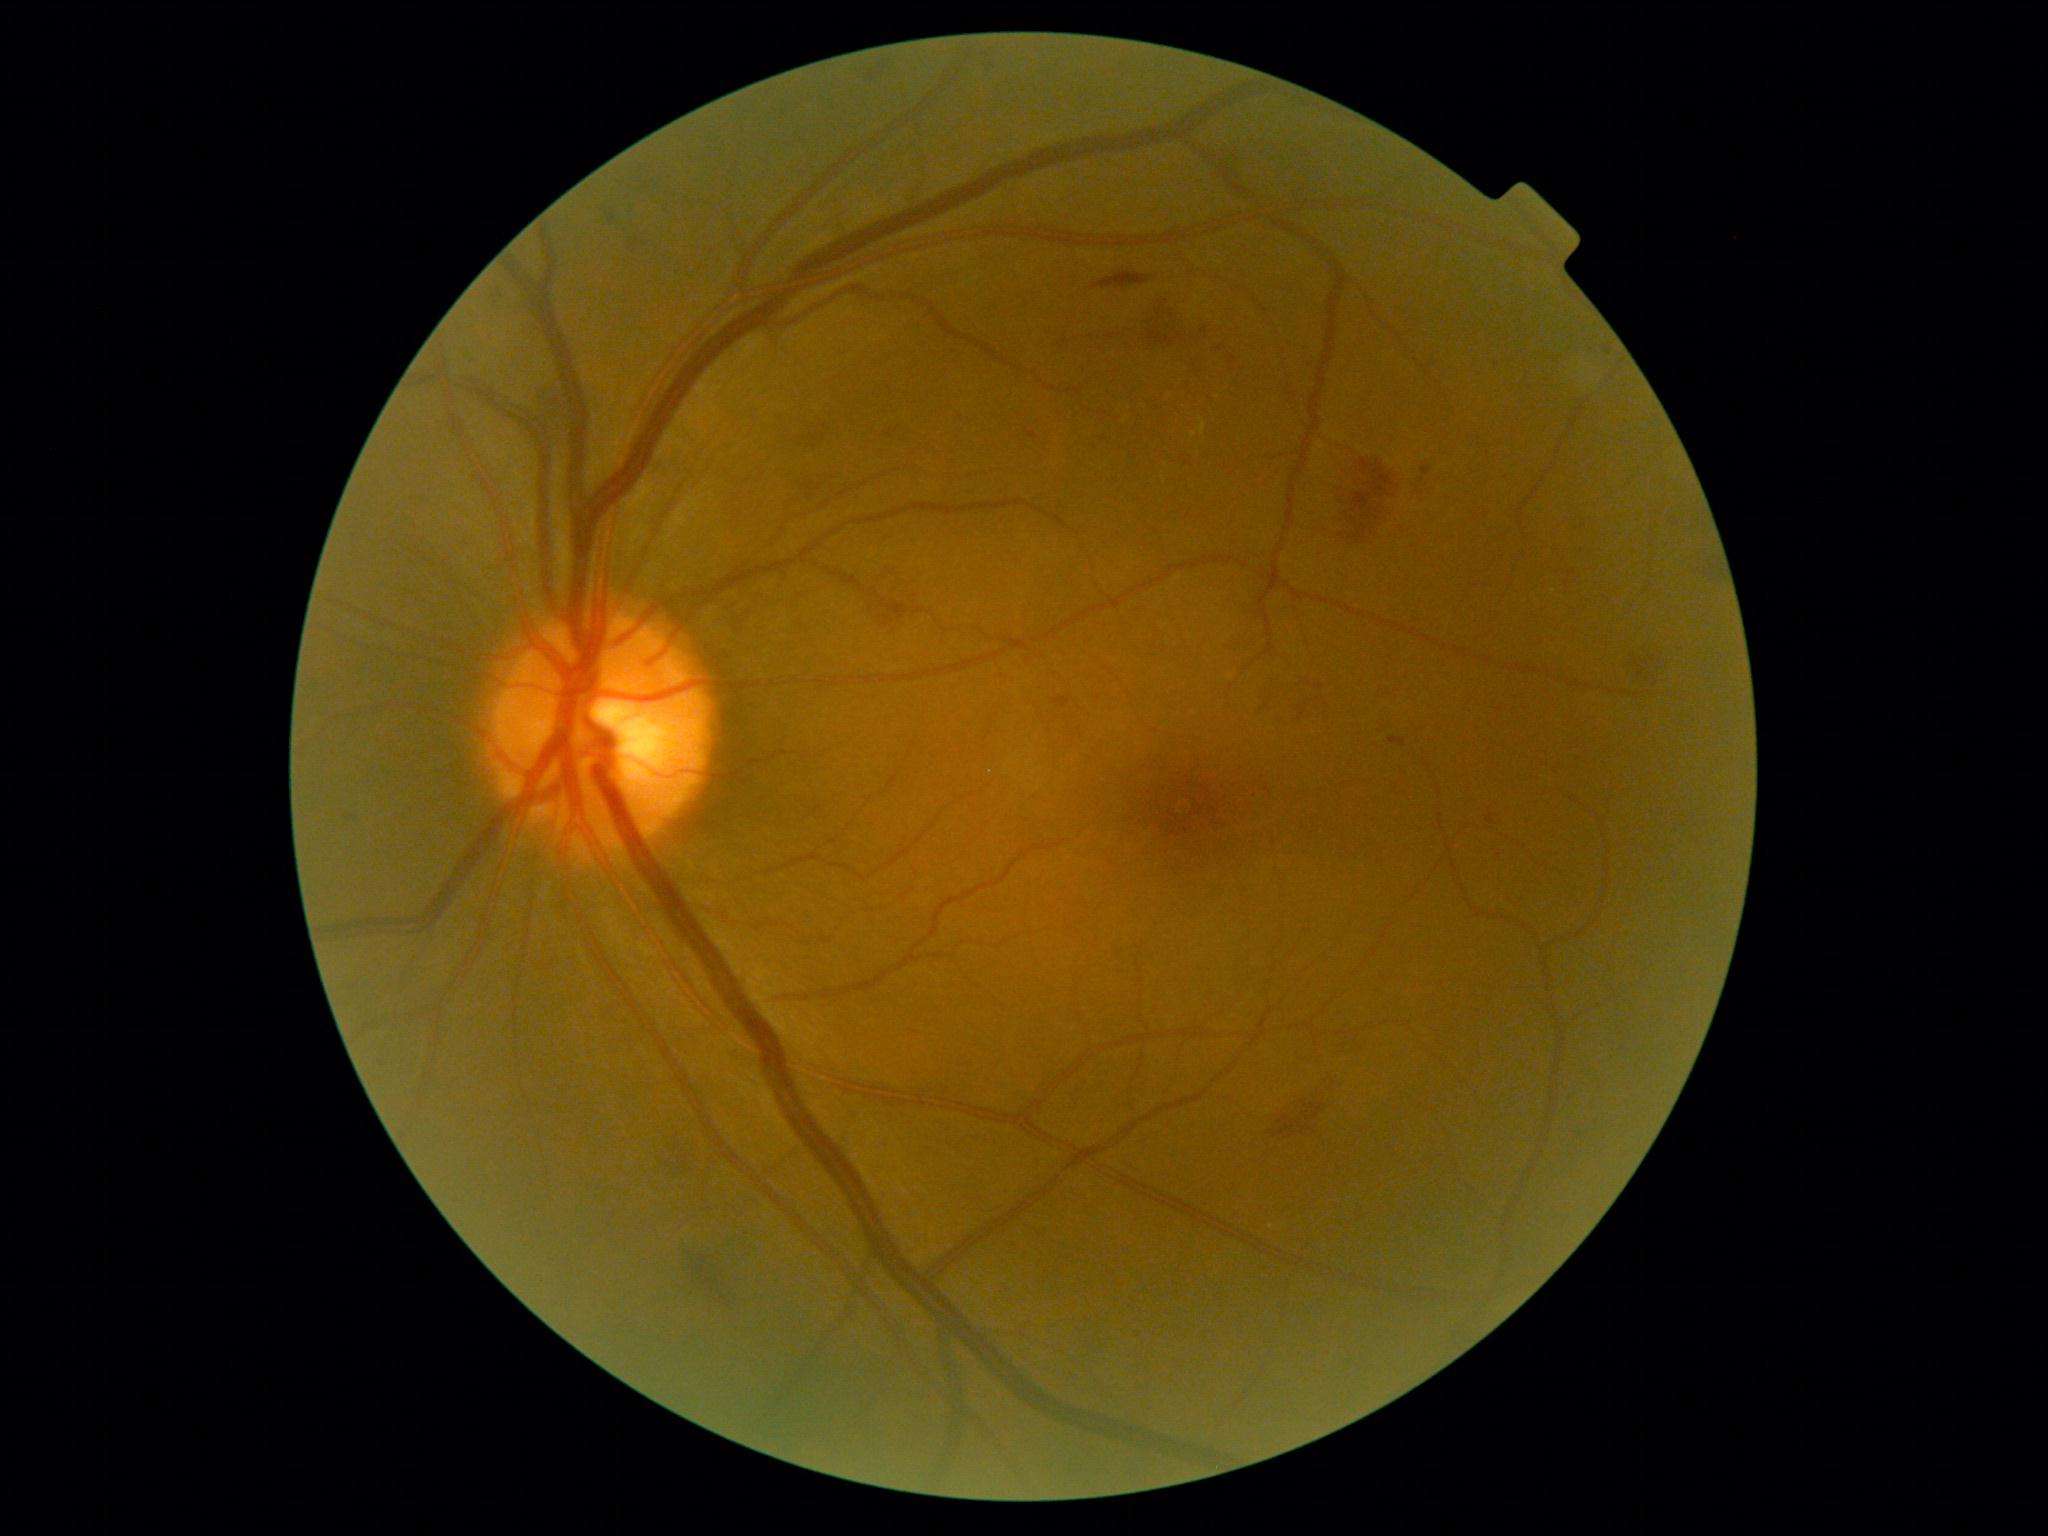

Diabetic retinopathy (DR) is grade 2 — more than just microaneurysms but less than severe NPDR
Selected lesions:
hemorrhages (HEs) (partial): (1336,460,1405,552); (869,569,918,631); (1269,1100,1325,1141); (1315,1082,1341,1102); (595,208,618,227); (1333,1040,1365,1052); (800,428,832,454); (1220,161,1241,180); (622,238,635,256); (1092,273,1151,290); (1695,559,1725,583); (1267,685,1274,704)